Nonmydriatic · graded on the modified Davis scale
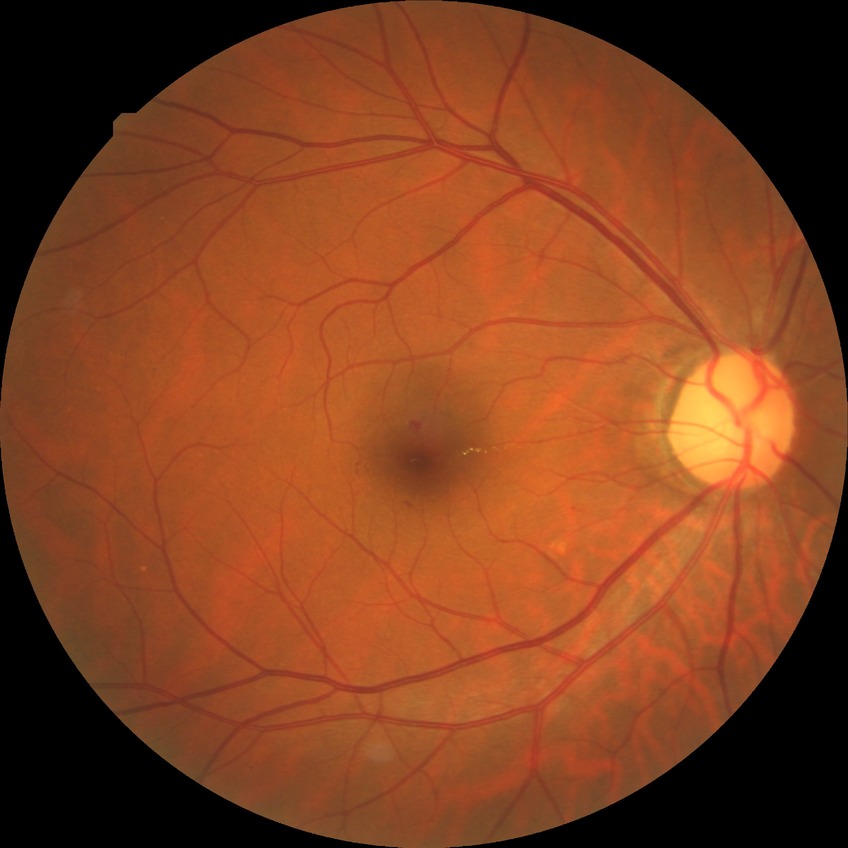 DR severity is SDR. DR class: non-proliferative diabetic retinopathy.